FOV: 45 degrees, color fundus image.
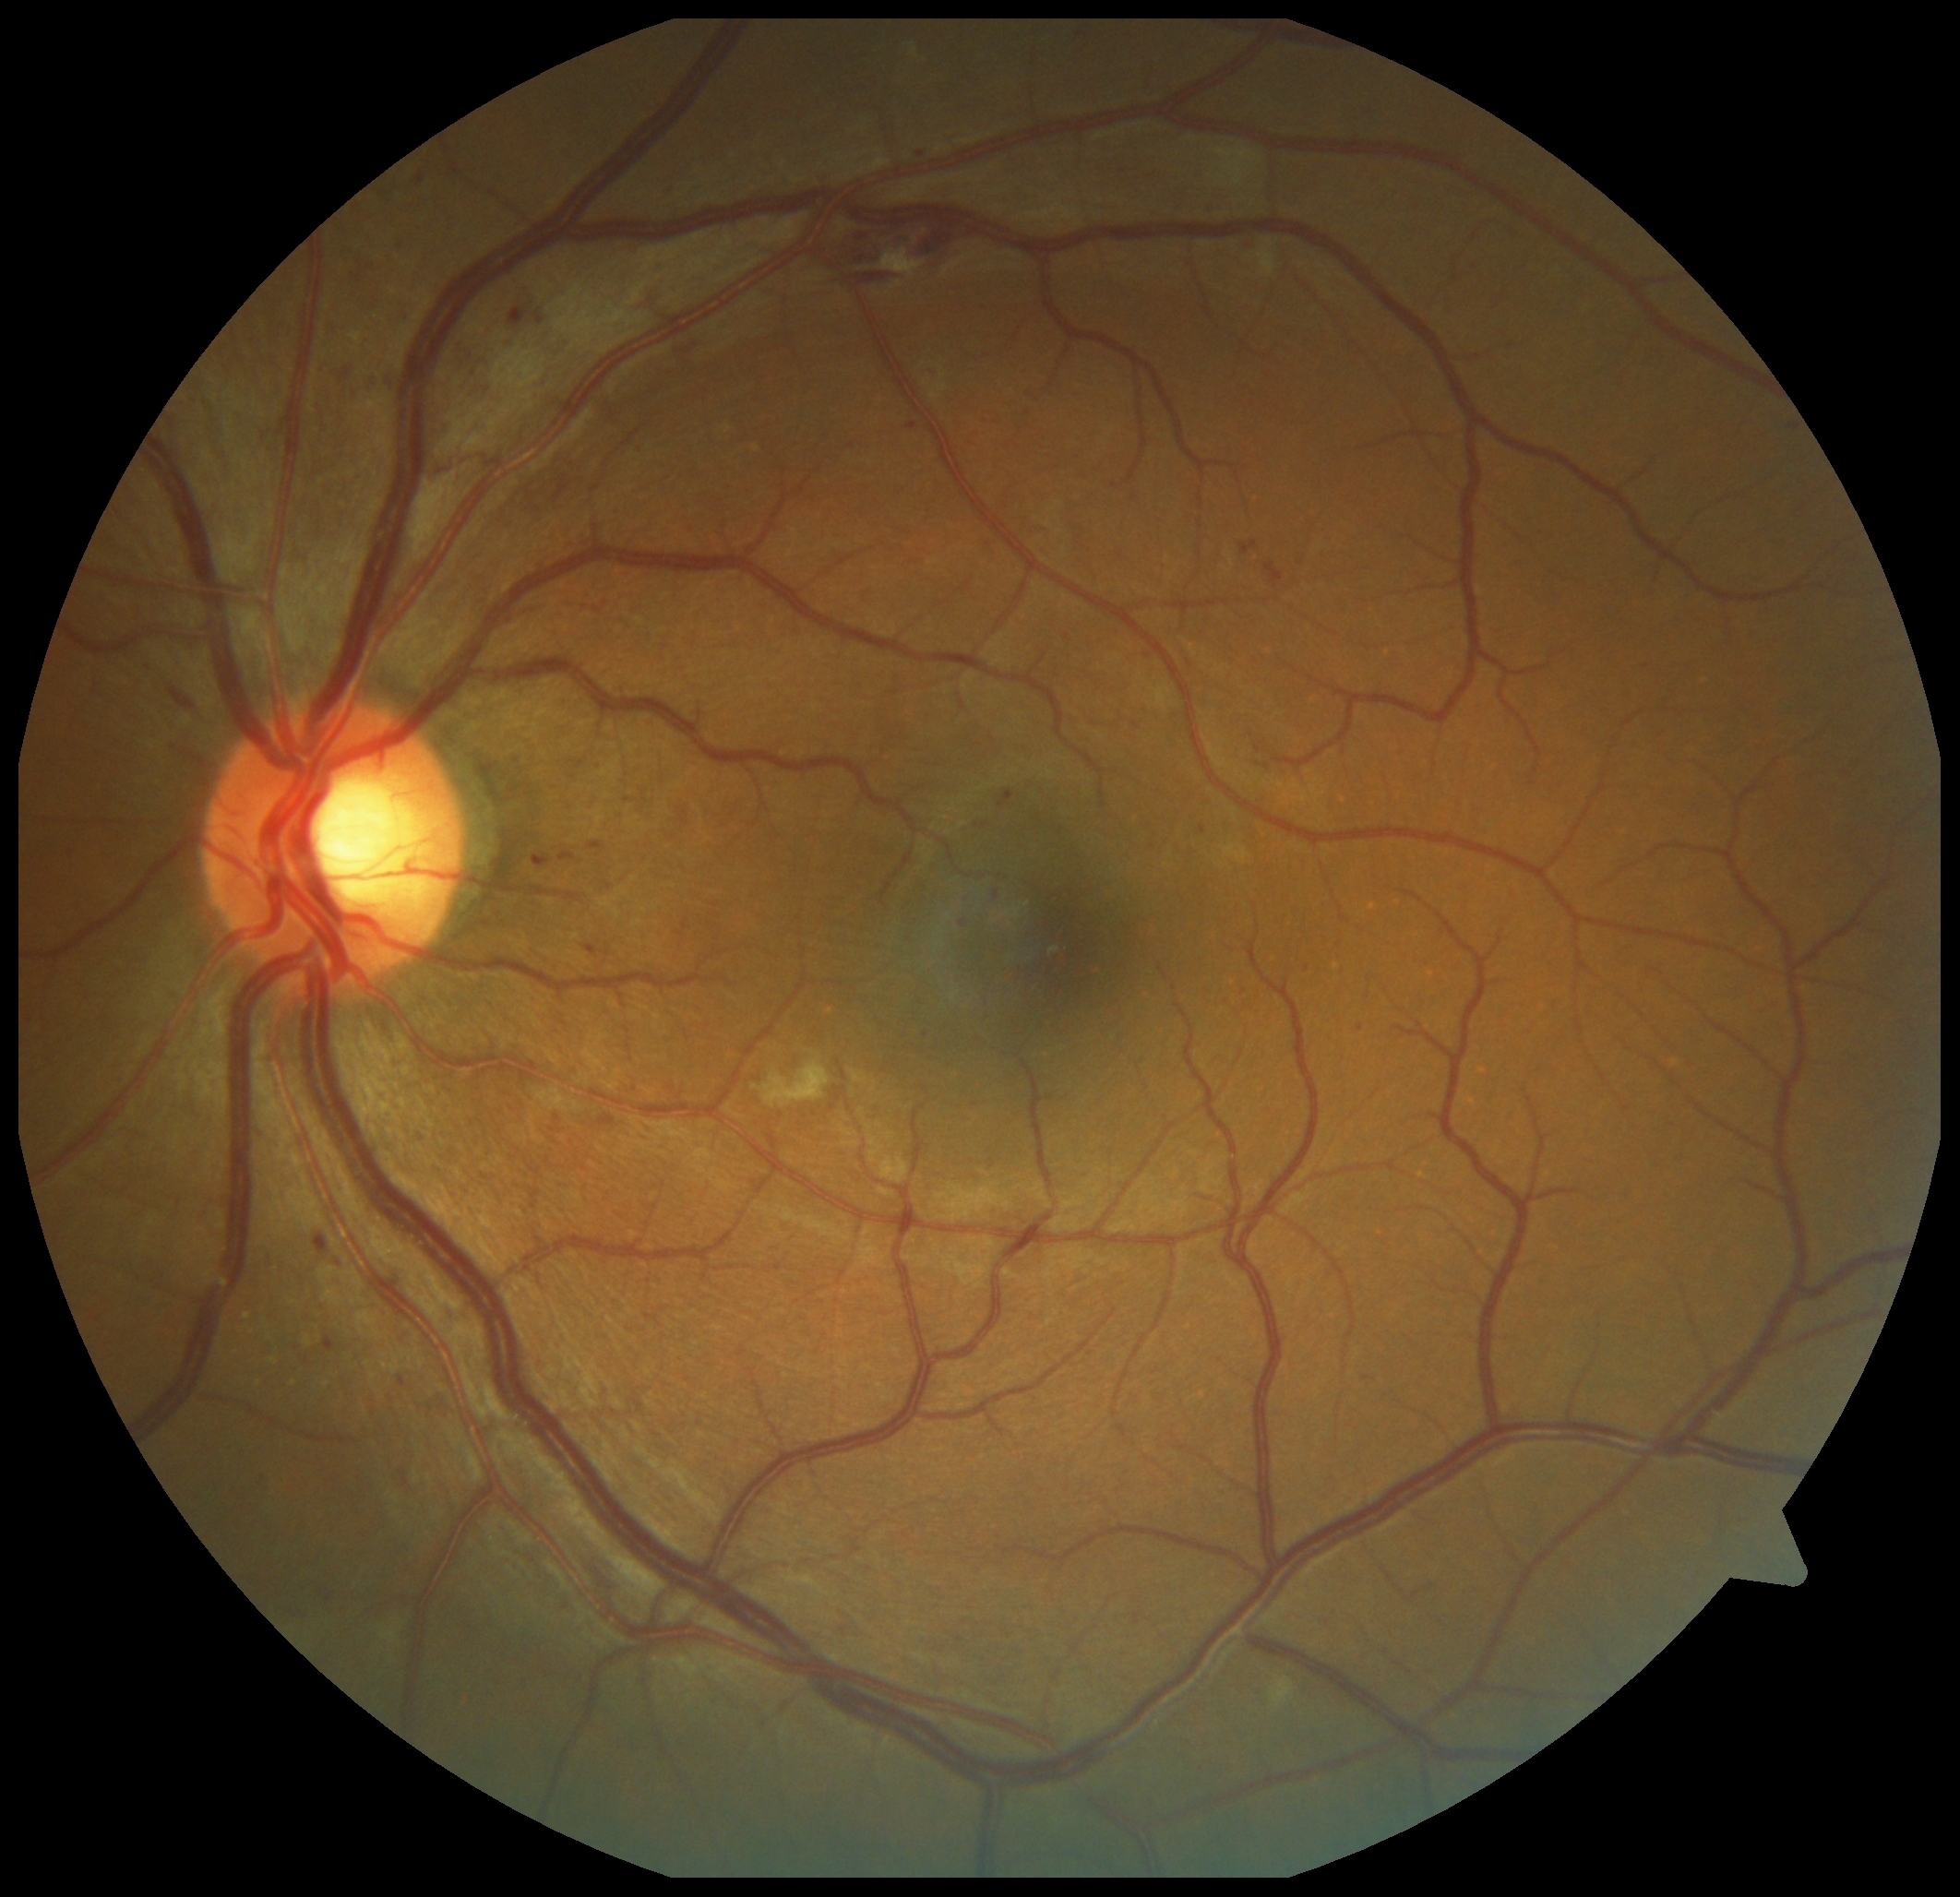

Diabetic retinopathy (DR) is 2
Representative lesions:
hemorrhages (HEs): left=170, top=696, right=201, bottom=720, left=1265, top=562, right=1284, bottom=587, left=835, top=222, right=968, bottom=284
microaneurysms (MAs) (more not shown): left=1256, top=746, right=1261, bottom=754, left=252, top=1474, right=269, bottom=1488, left=959, top=921, right=968, bottom=928, left=418, top=175, right=425, bottom=186, left=600, top=1116, right=615, bottom=1127, left=384, top=378, right=391, bottom=388, left=397, top=1375, right=406, bottom=1387, left=540, top=853, right=555, bottom=866, left=459, top=353, right=469, bottom=365, left=397, top=245, right=406, bottom=258, left=509, top=308, right=527, bottom=326, left=1240, top=542, right=1258, bottom=556
MAs (small, approximate centers) near (922, 156), (1308, 970), (557, 1118), (360, 280), (1362, 1029)
soft exudates (SEs): left=880, top=250, right=925, bottom=279, left=754, top=1060, right=831, bottom=1109, left=1258, top=246, right=1276, bottom=277, left=1271, top=1677, right=1296, bottom=1708
hard exudates (EXs): none